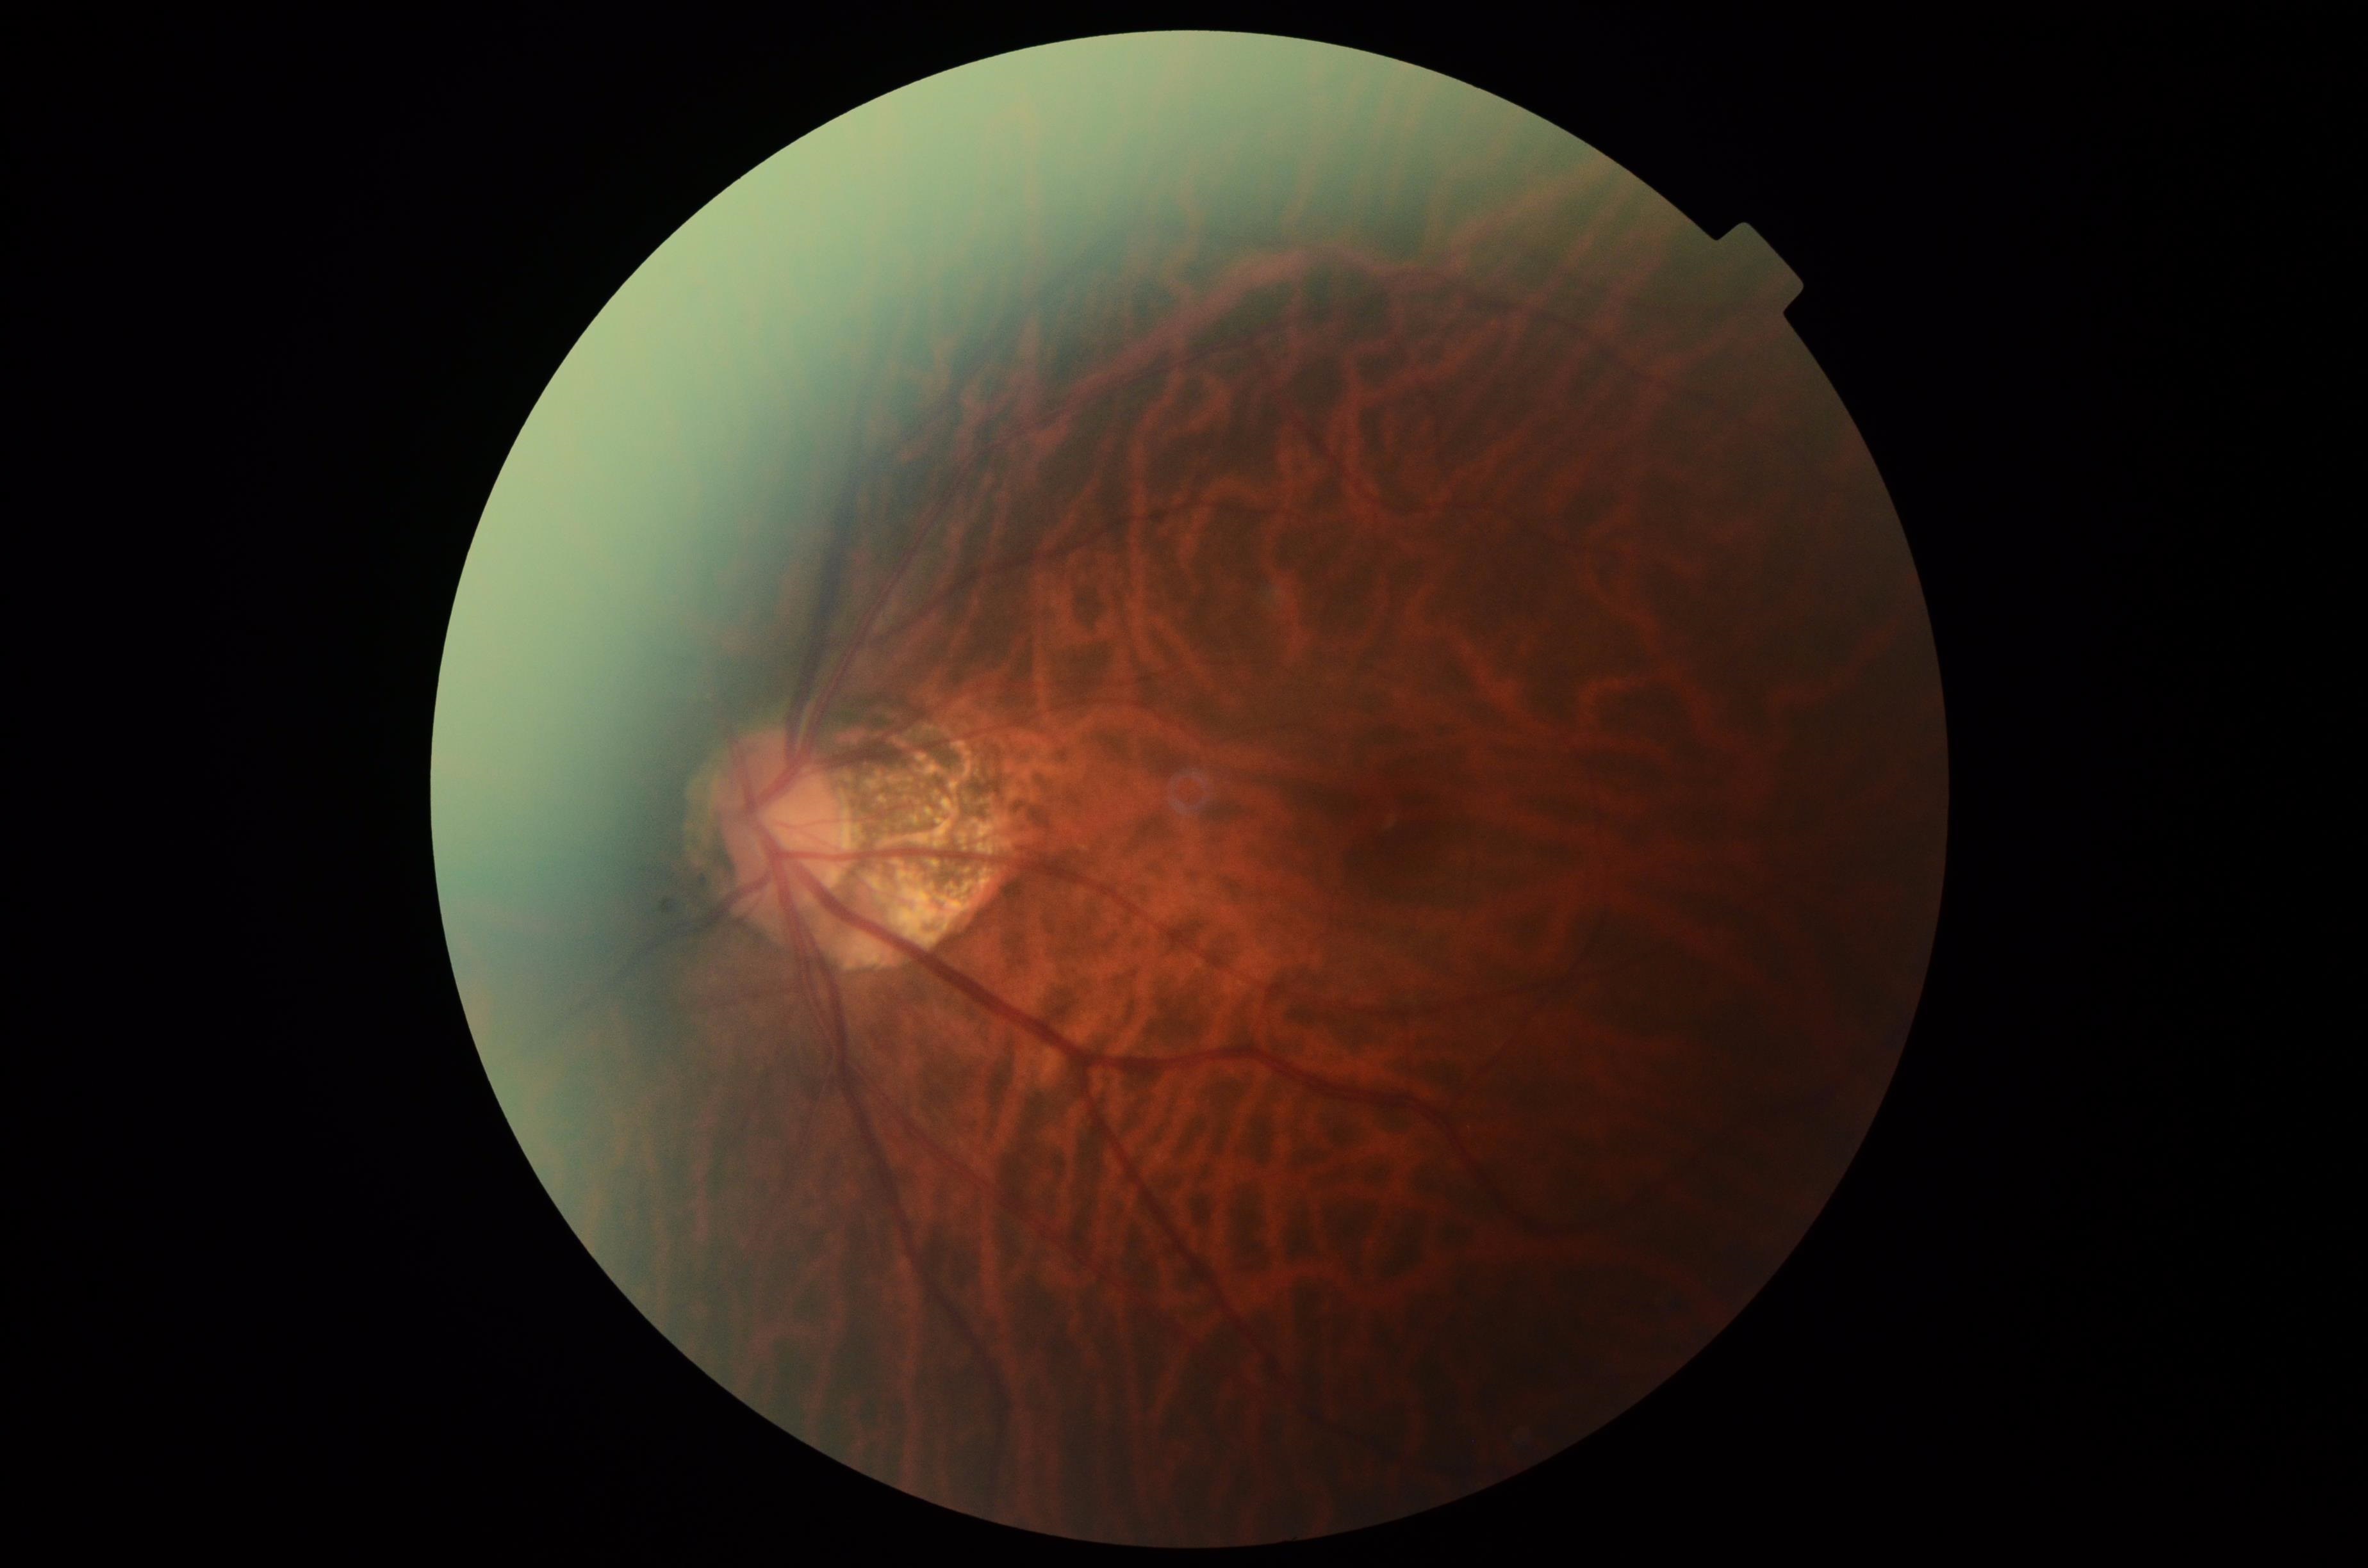
No signs of diabetic retinopathy. Diabetic retinopathy (DR) is no apparent retinopathy (grade 0).